NIDEK AFC-230, 45-degree field of view, without pupil dilation
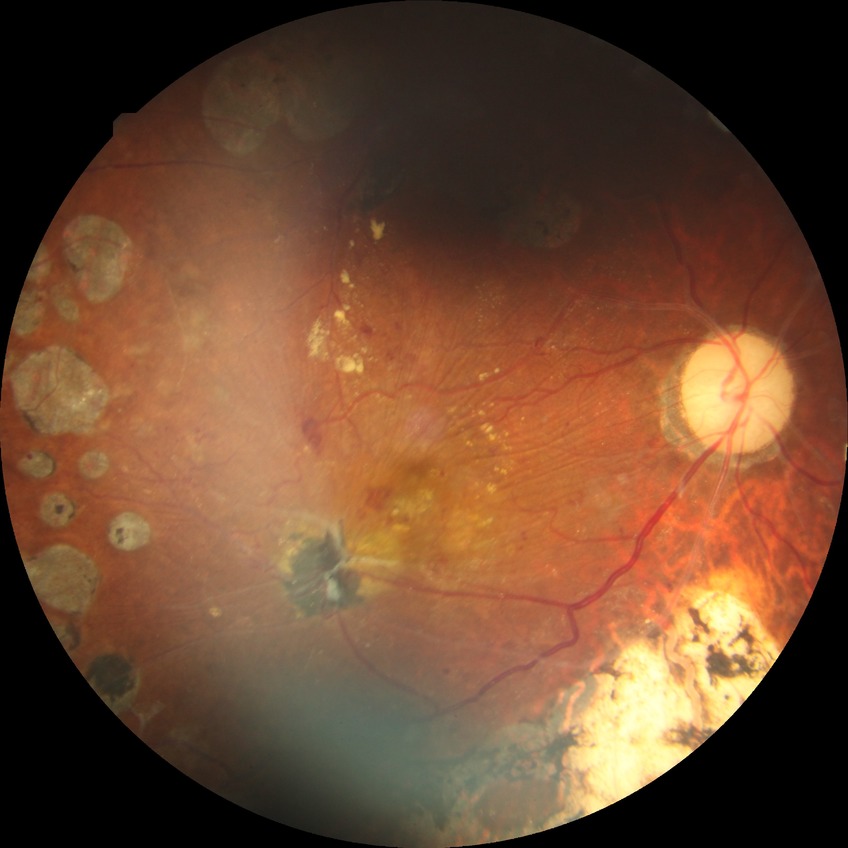 Diabetic retinopathy grade is proliferative diabetic retinopathy.